Infant wide-field retinal image — 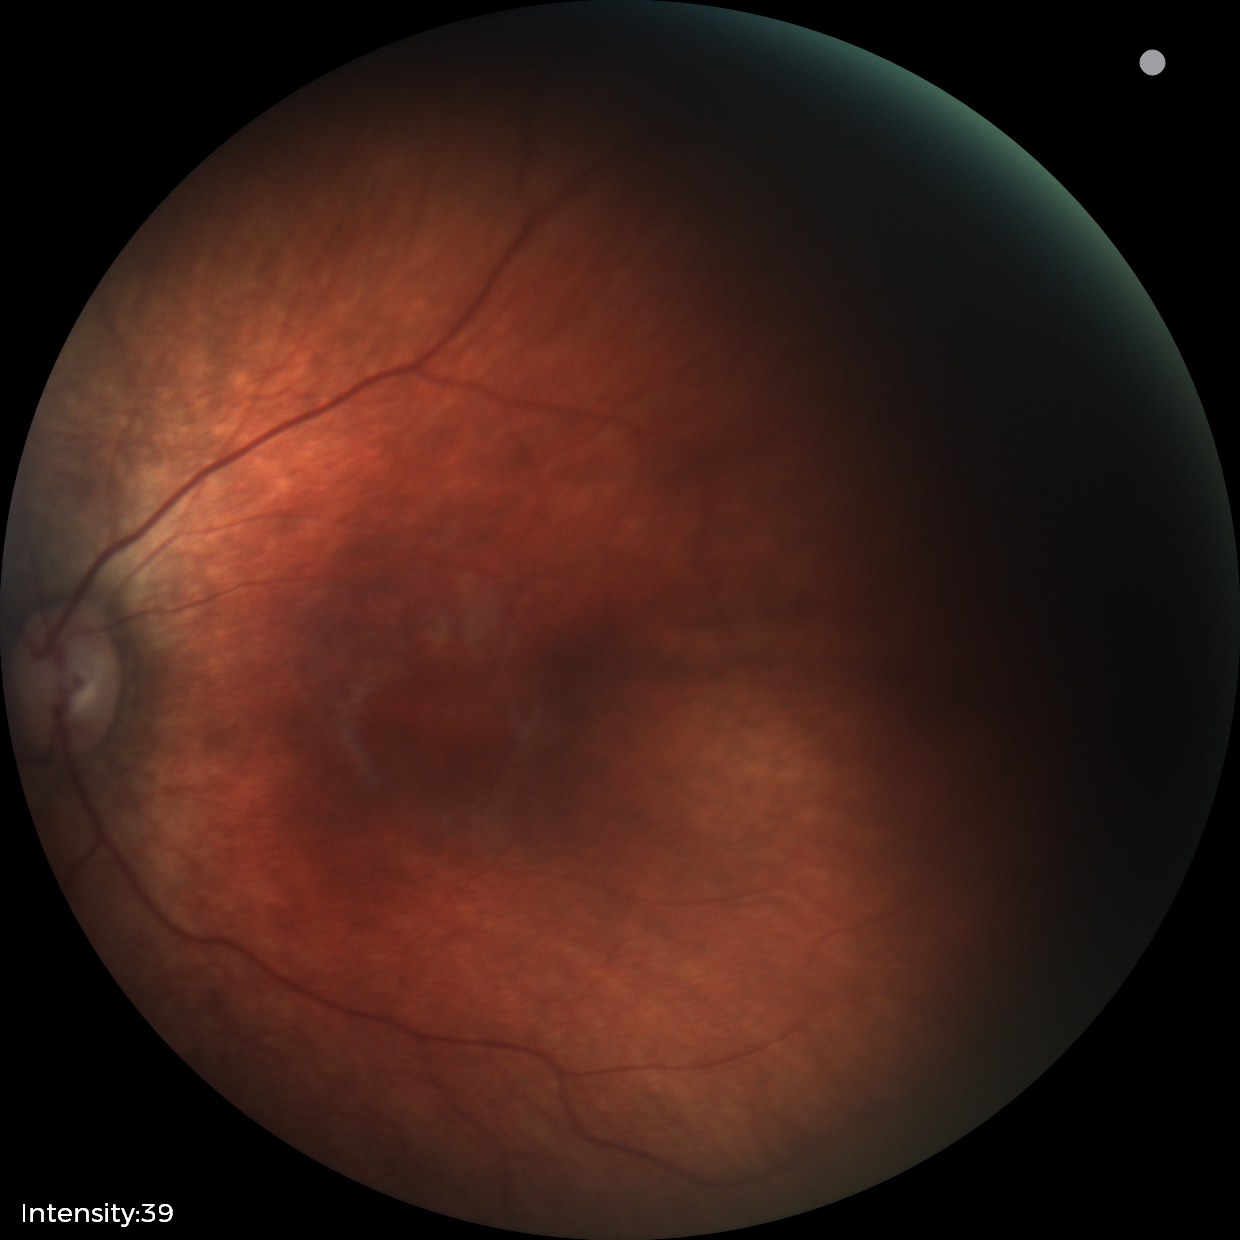
Finding: physiological appearance.